Pediatric wide-field fundus photograph:
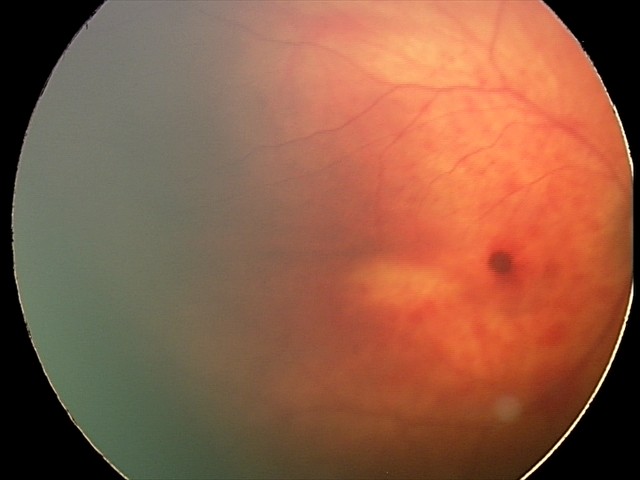 From an examination with diagnosis of retinal hemorrhages.